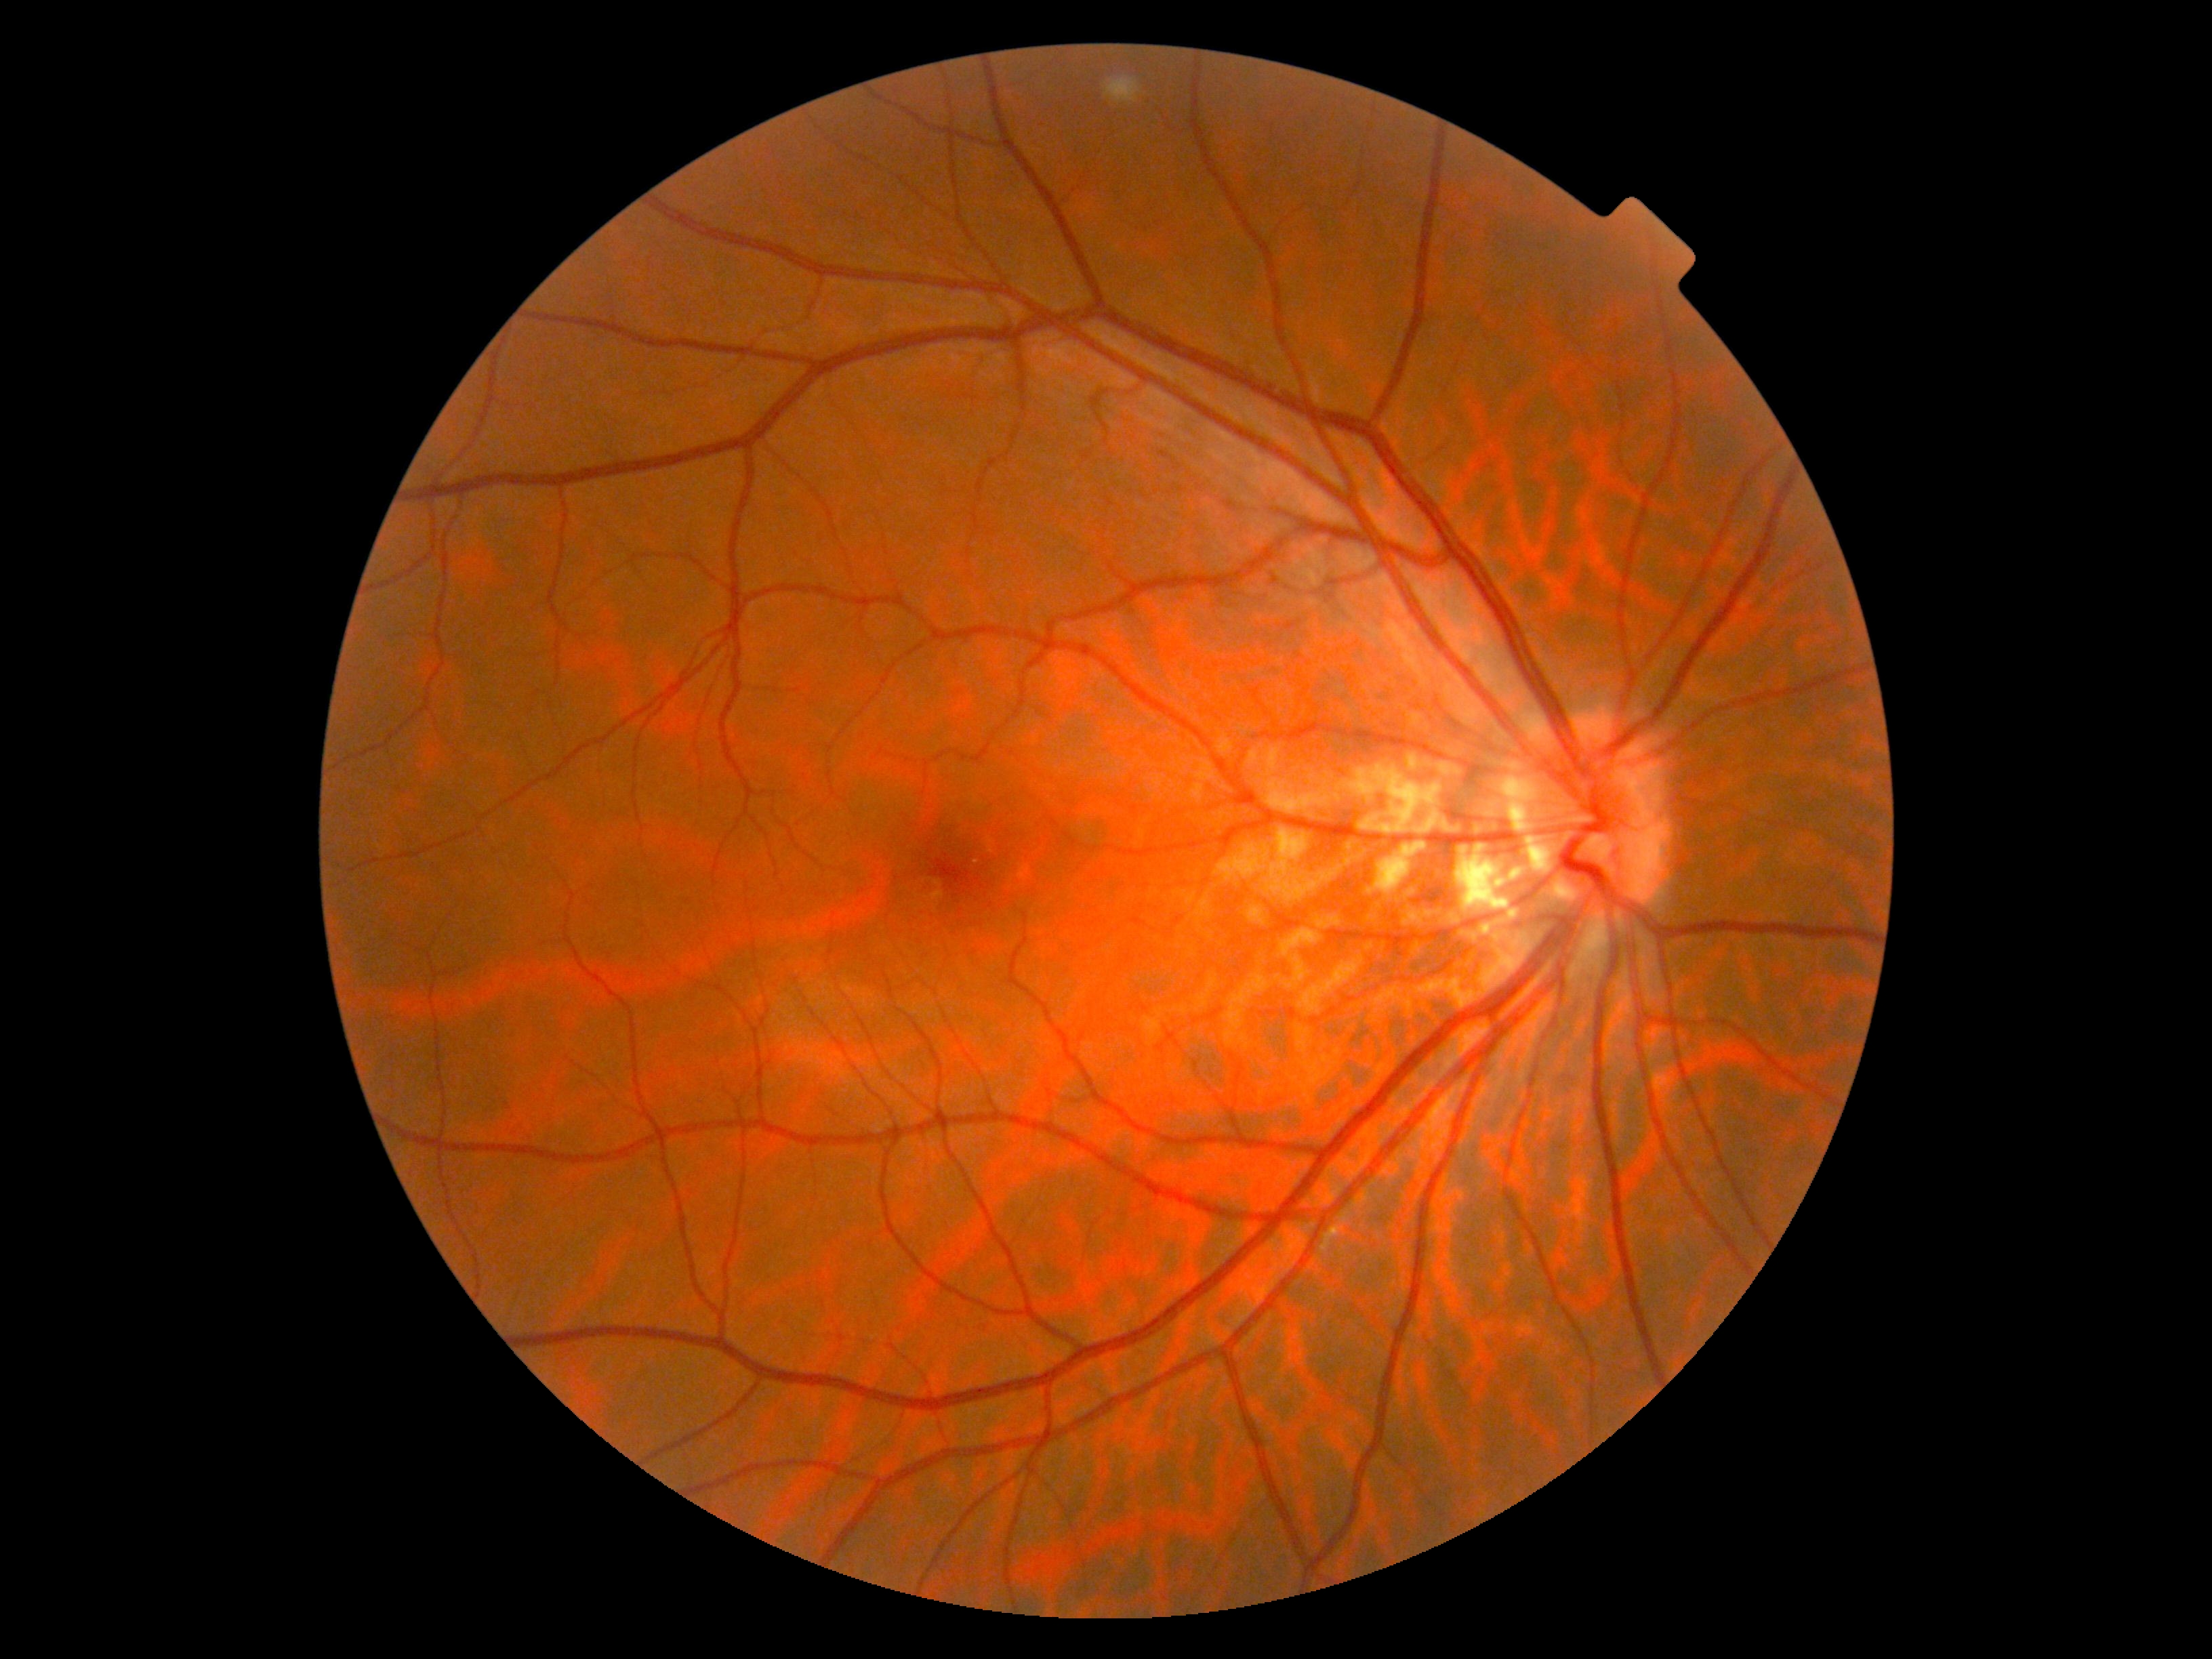
– DR impression: no DR findings
– retinopathy: no apparent diabetic retinopathy (grade 0)